2048x1536px.
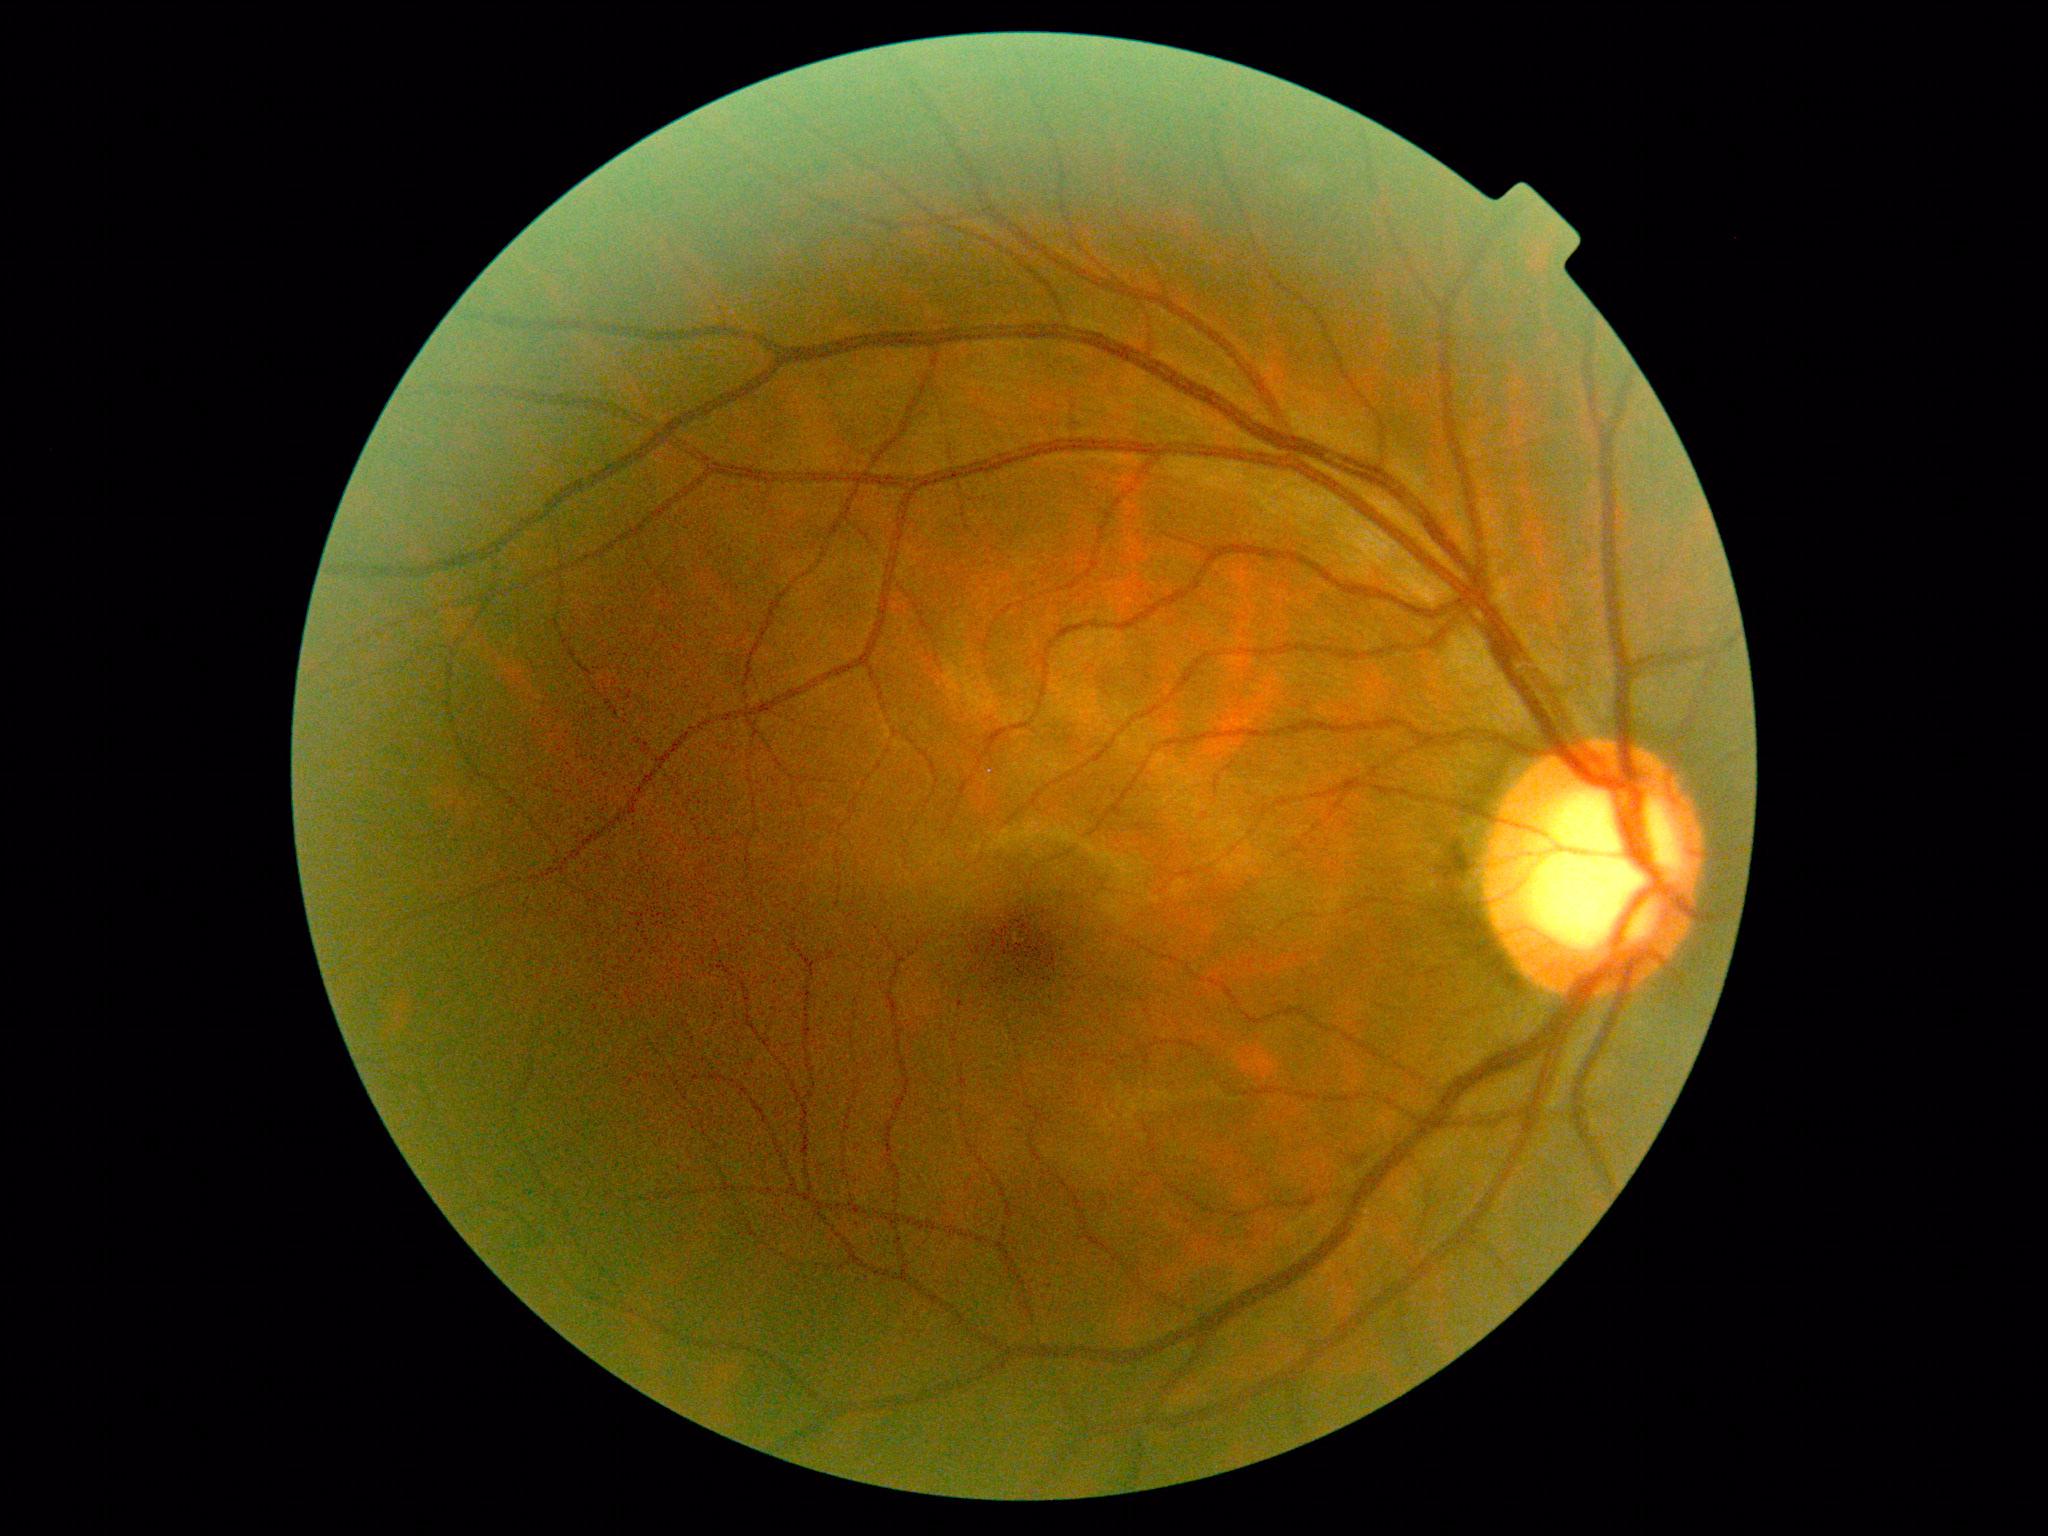 DR stage is grade 0 (no apparent retinopathy).